Phoenix ICON wide-field infant fundus image
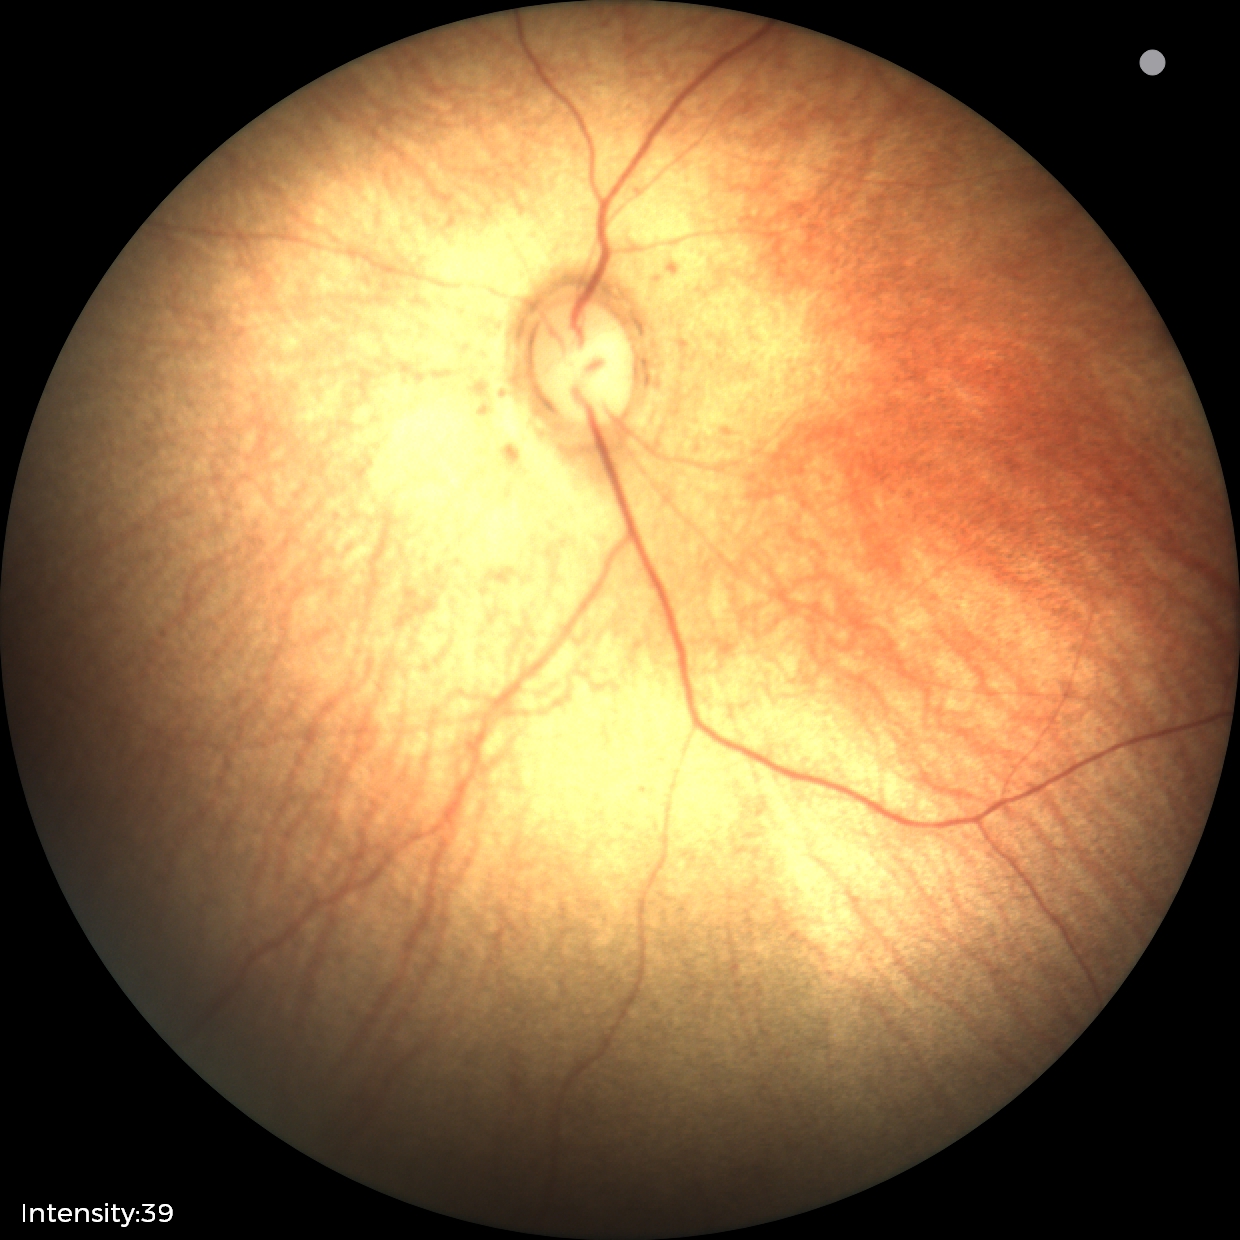

Assessment: no pathology identified.